640x480px; wide-field fundus photograph from neonatal ROP screening; camera: Clarity RetCam 3 (130° FOV)
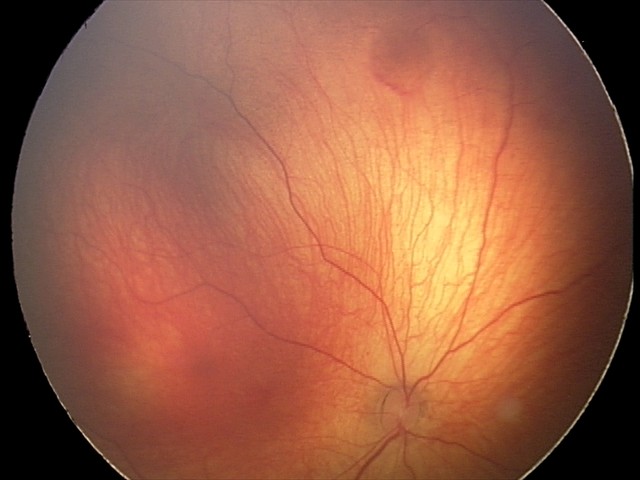

Diagnosis from this screening exam: retinal hemorrhages.